Captured after pupil dilation.
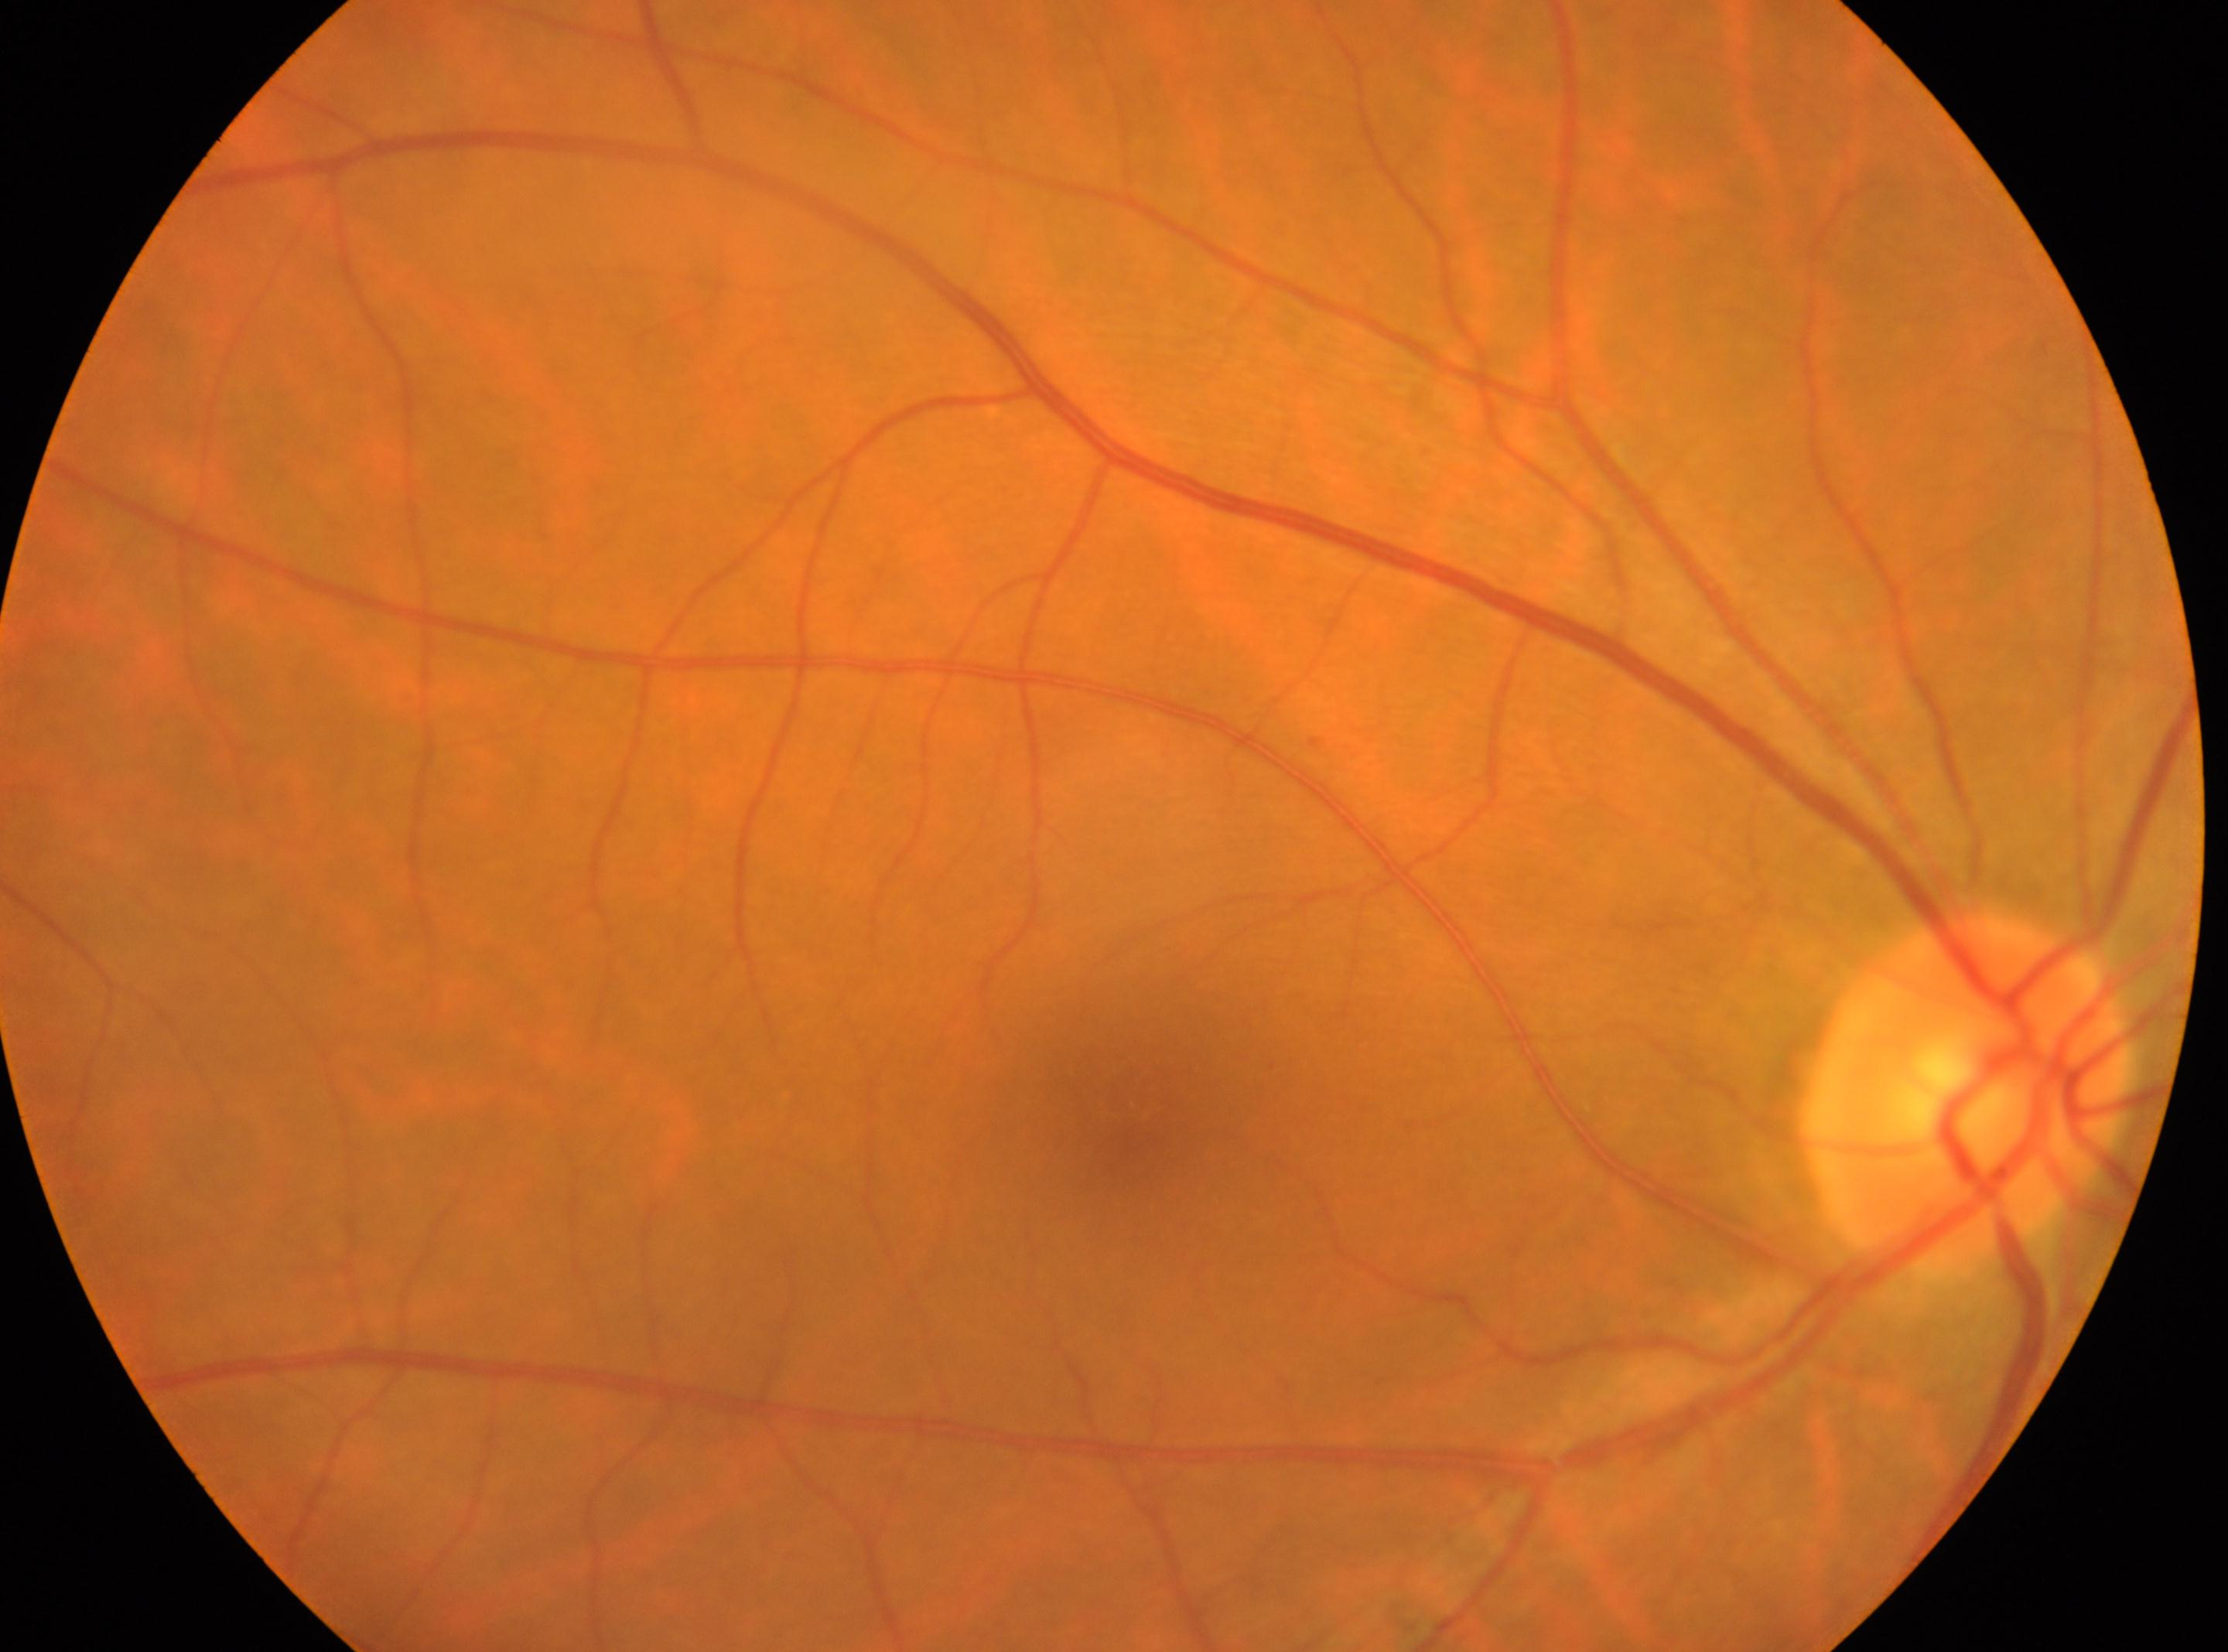

DR stage: 0/4 — no visible signs of diabetic retinopathy.
Imaged eye: right.
Fovea: 1129, 1091.
Optic disk located at 1965, 1095.